FOV: 45 degrees.
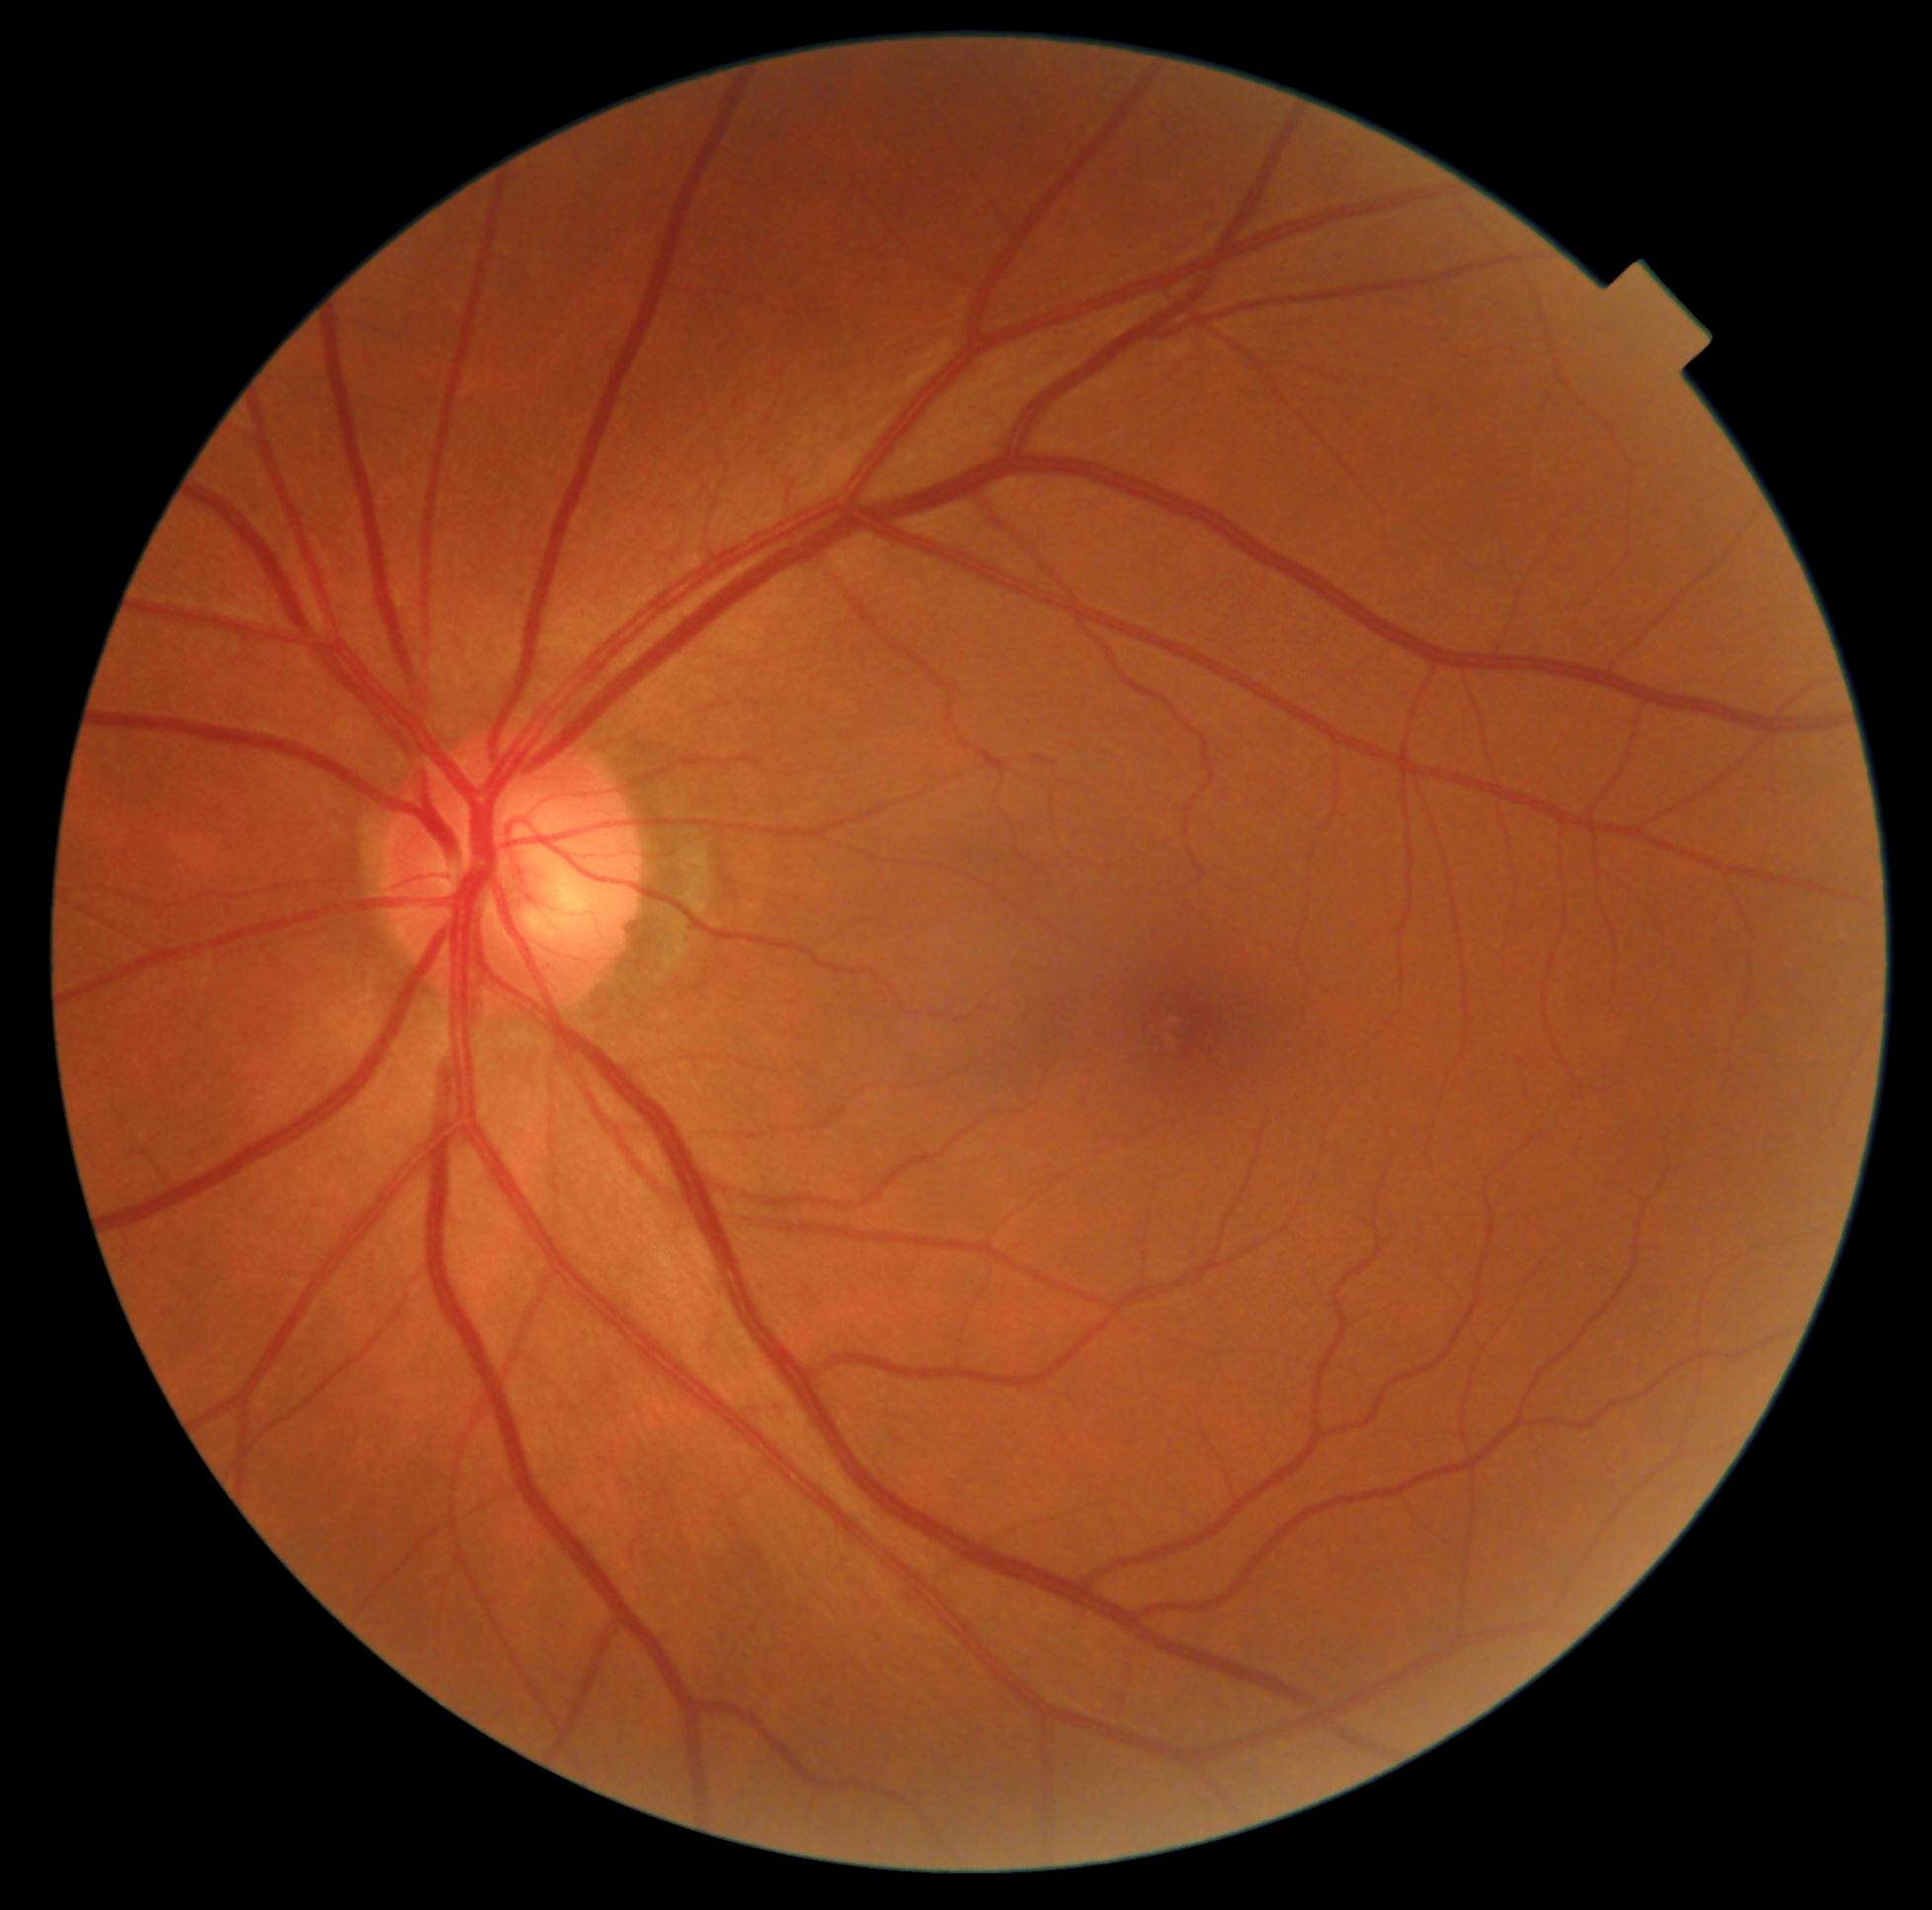

Diabetic retinopathy grade: 0 (no apparent retinopathy) — no visible signs of diabetic retinopathy. No diabetic retinal disease findings.